2352x1568px:
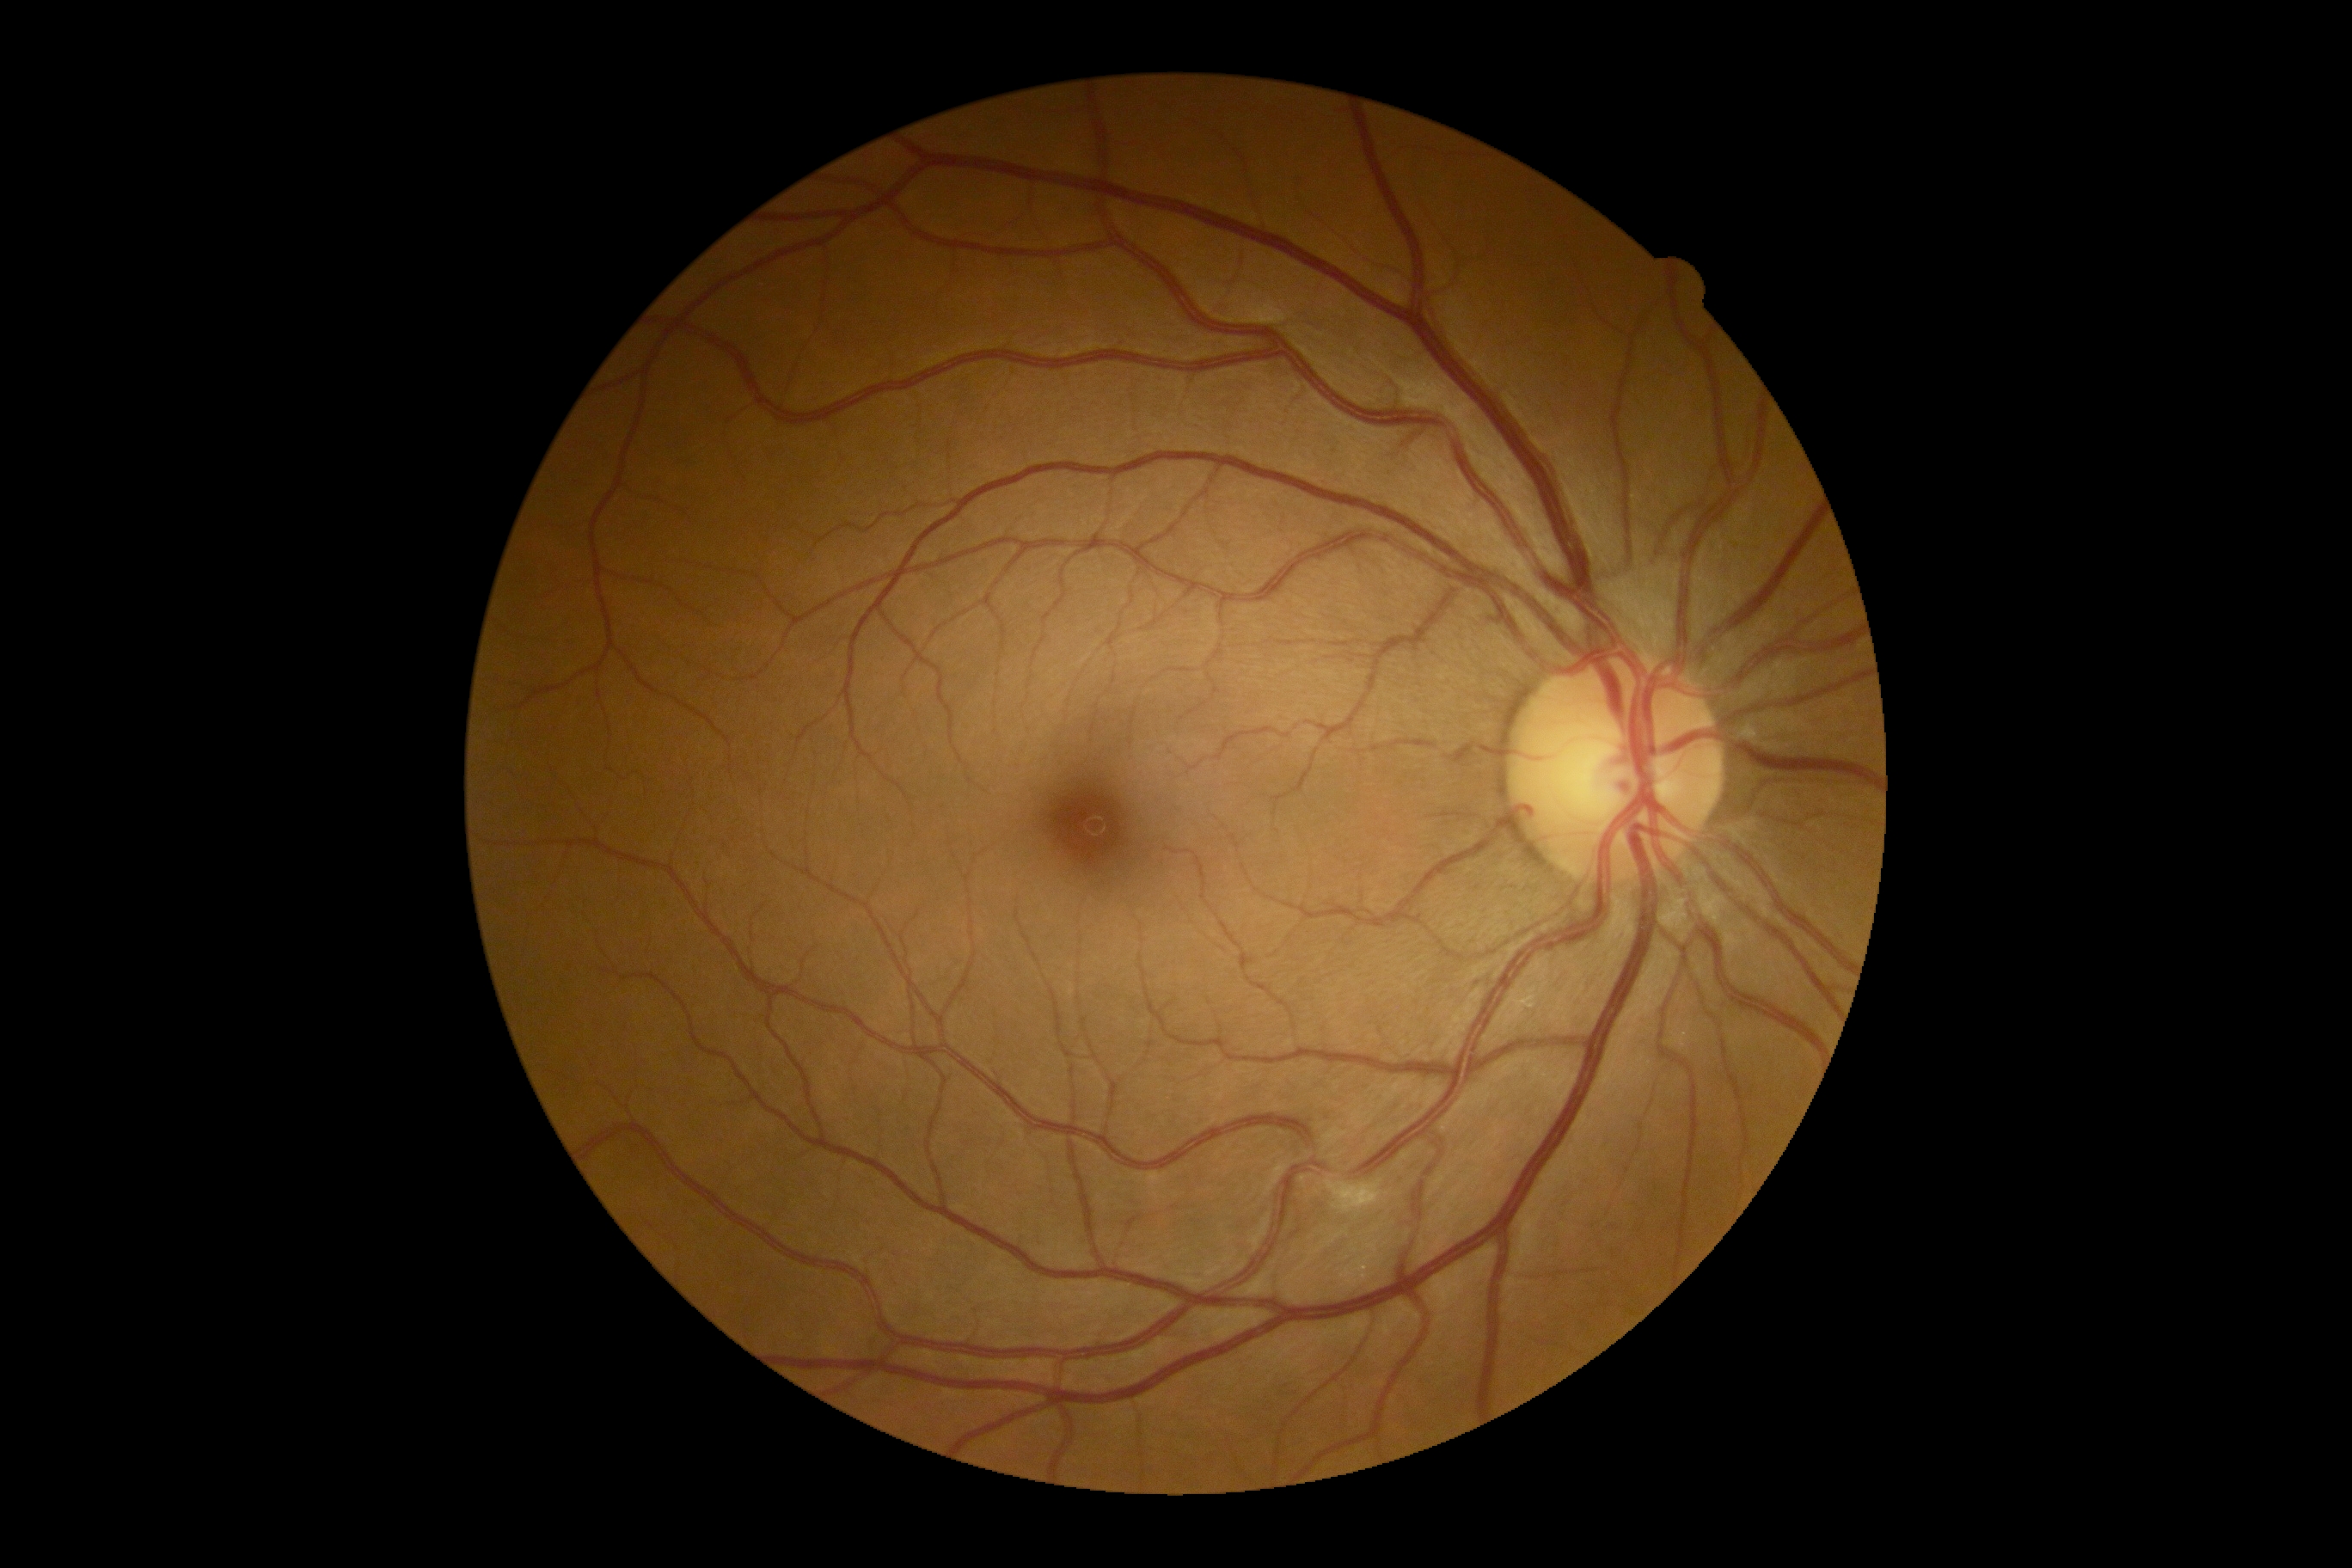 DR grade = 2
DR class = non-proliferative diabetic retinopathy